Ultra-widefield fundus mosaic:
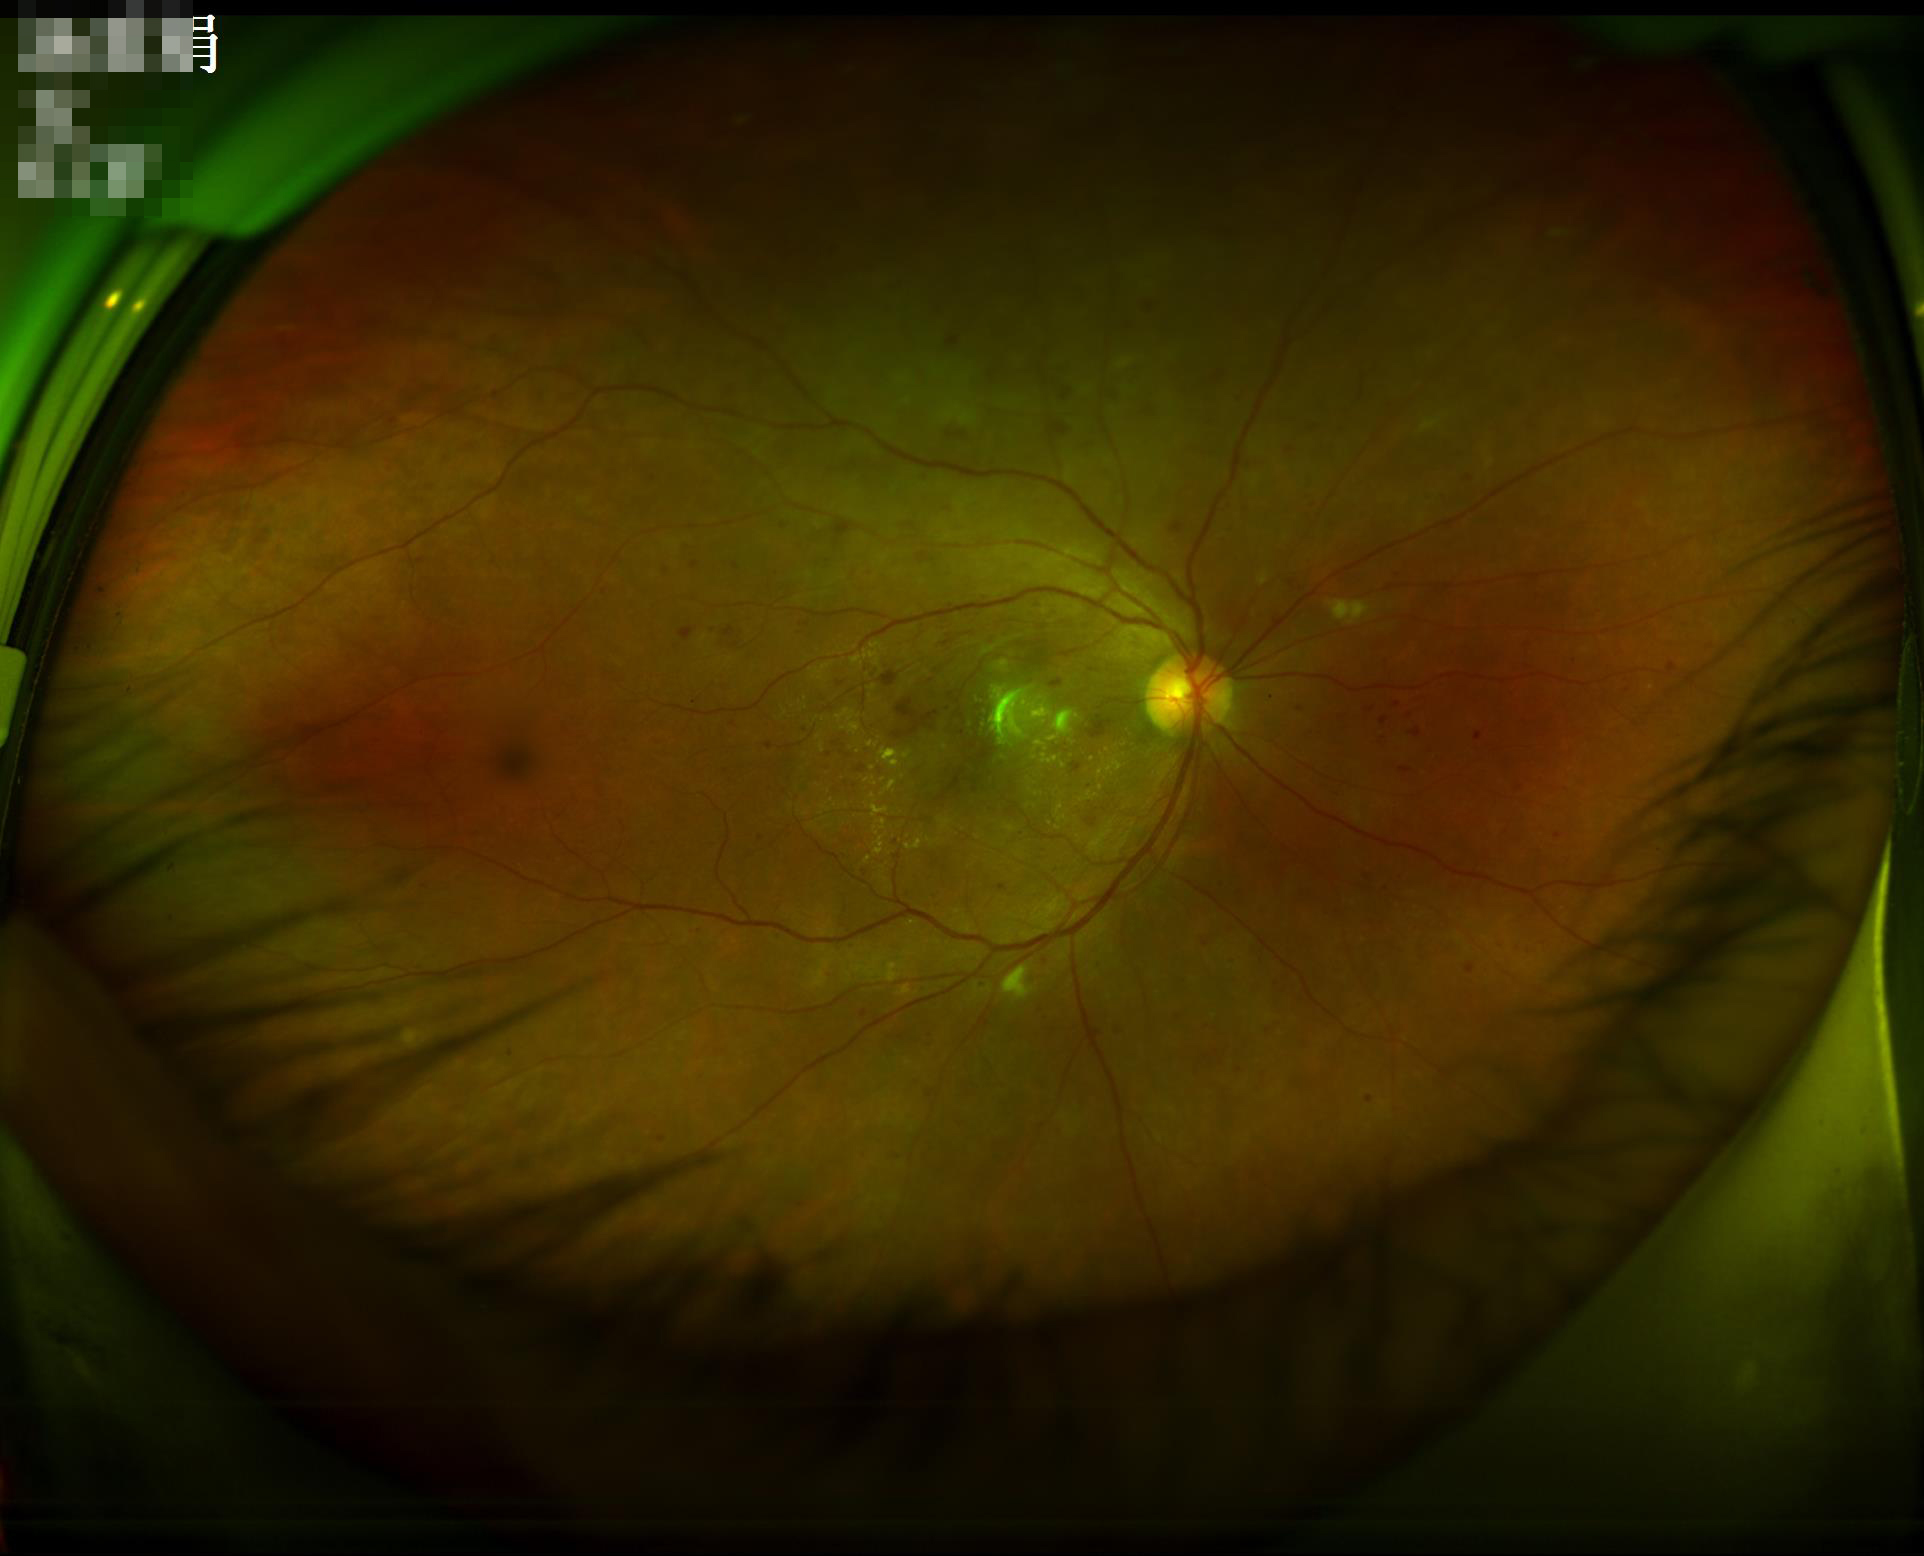
Overall = good; Contrast = adequate; Illumination/color = even; Clarity = sharp.